Pediatric wide-field fundus photograph; 640x480; Clarity RetCam 3, 130° FOV
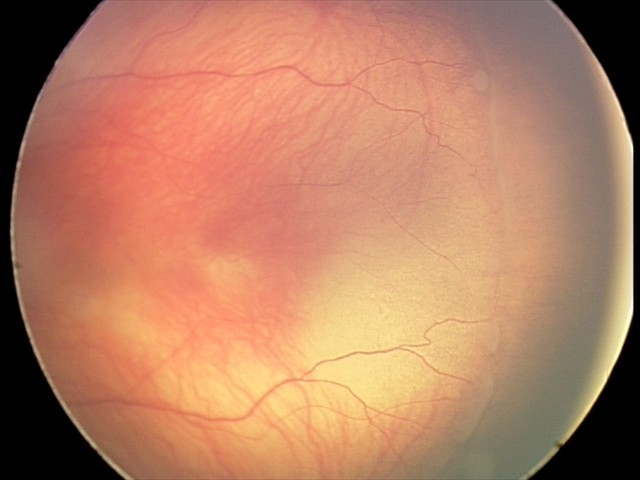

Examination diagnosed as ROP stage 1.